Without pupil dilation. Acquired with a NIDEK AFC-230. 848x848. Graded on the modified Davis scale. Color fundus photograph. 45-degree field of view
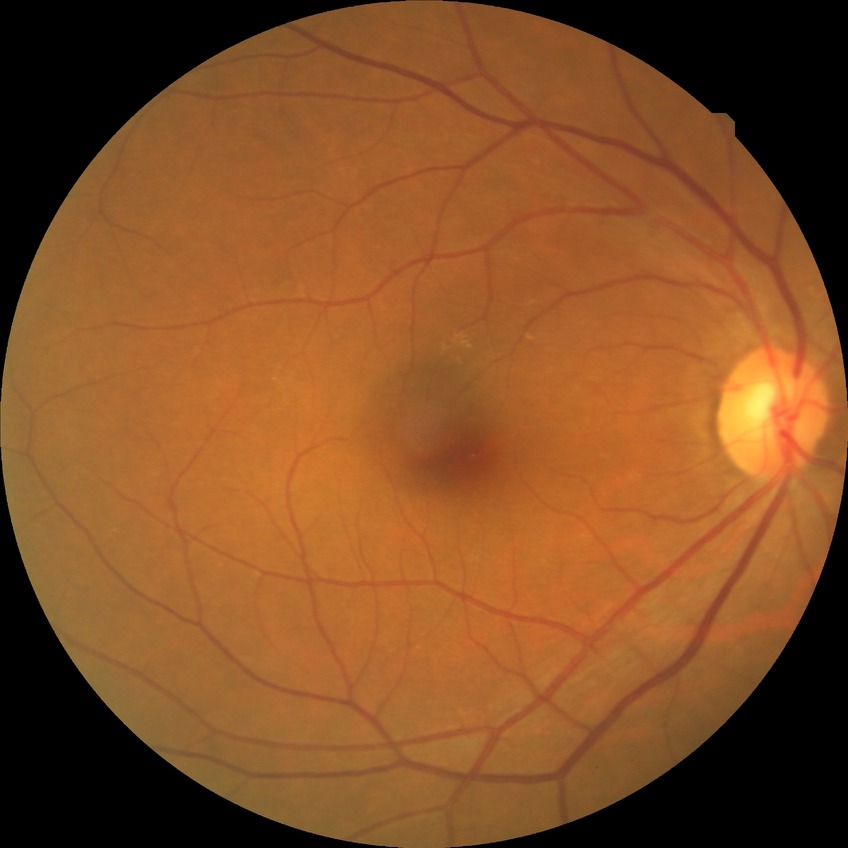

DR impression = no signs of DR
DR severity = NDR